Retinal fundus photograph · 848 by 848 pixels: 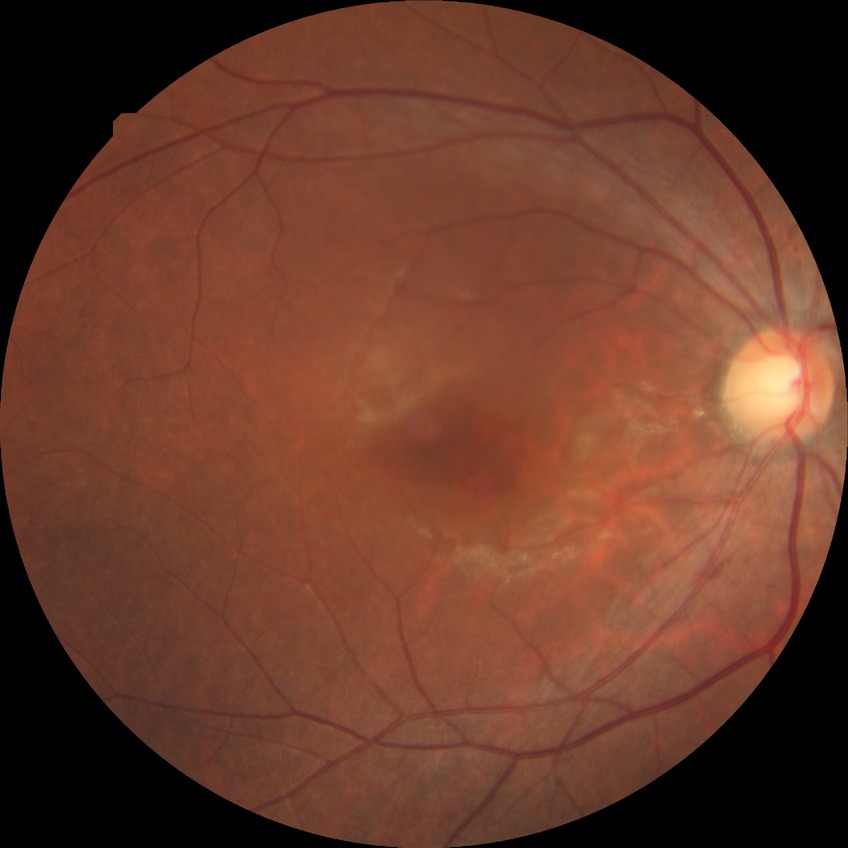
Diabetic retinopathy (DR) is NDR (no diabetic retinopathy).